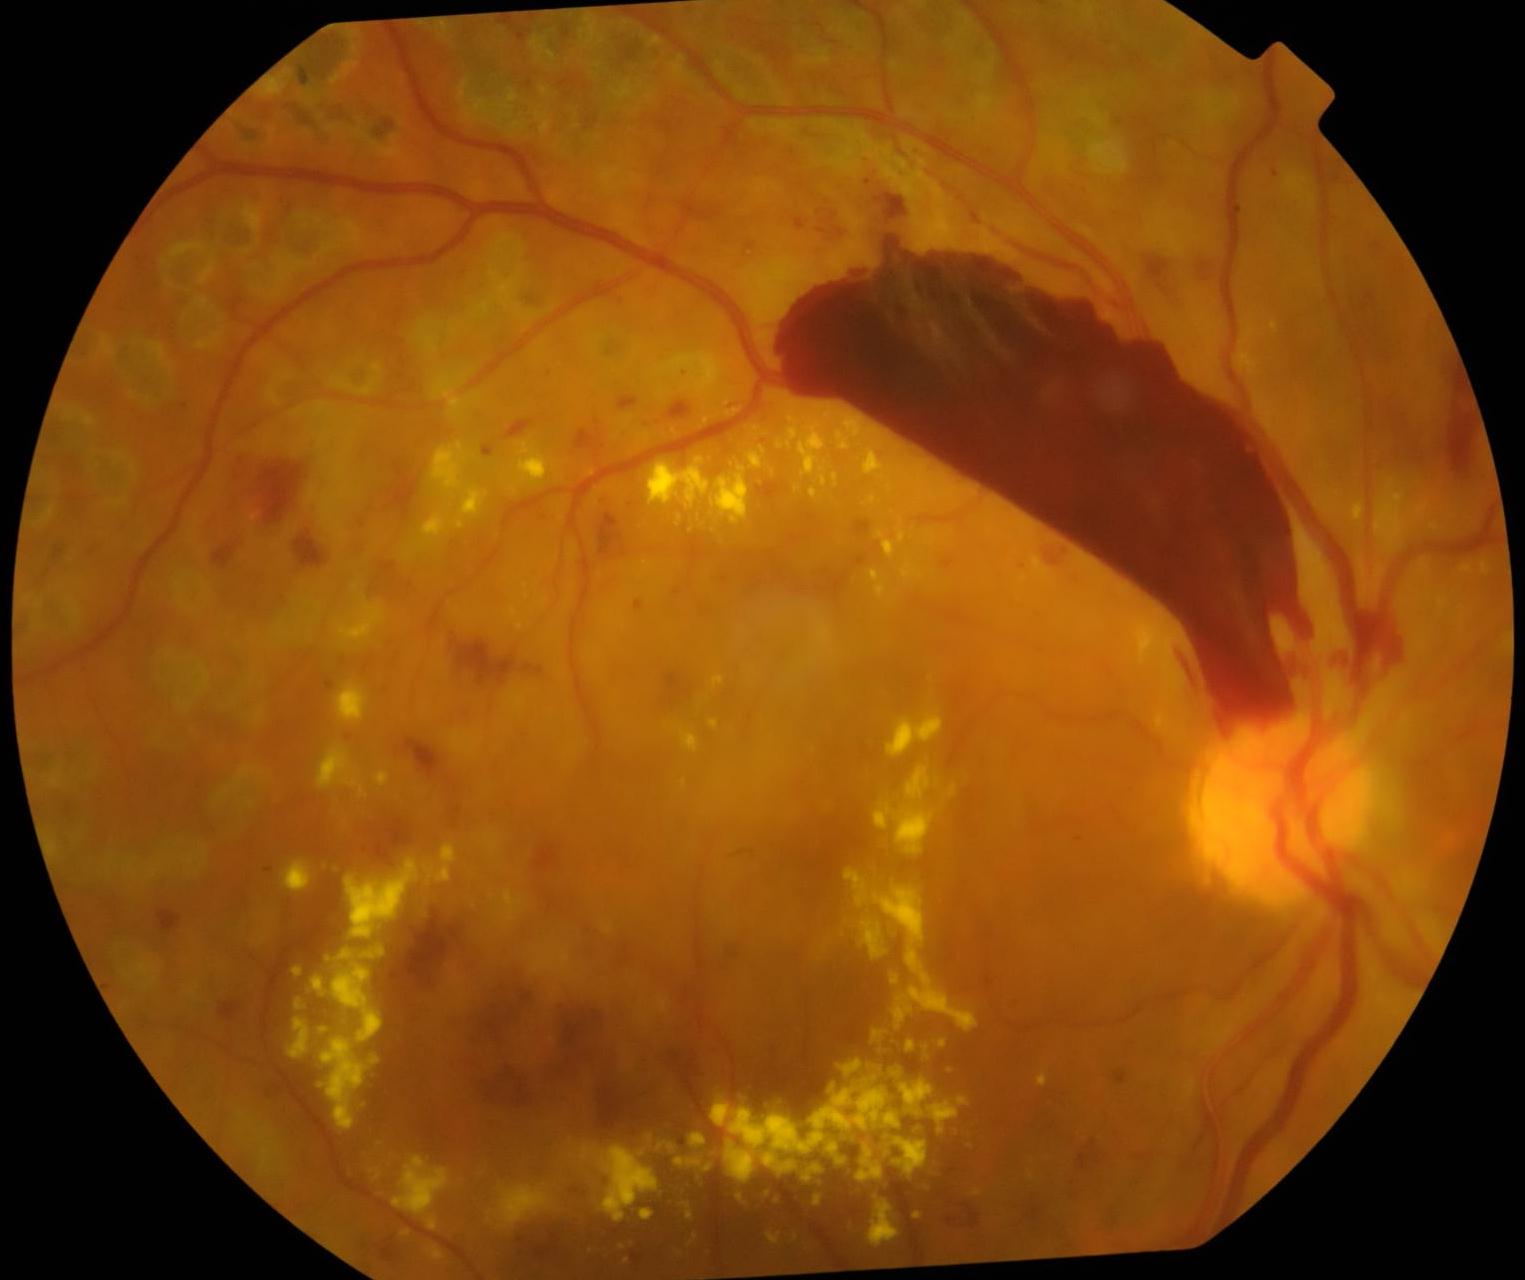

DR severity is proliferative diabetic retinopathy (grade 4) — neovascularization and/or vitreous/pre-retinal hemorrhage.